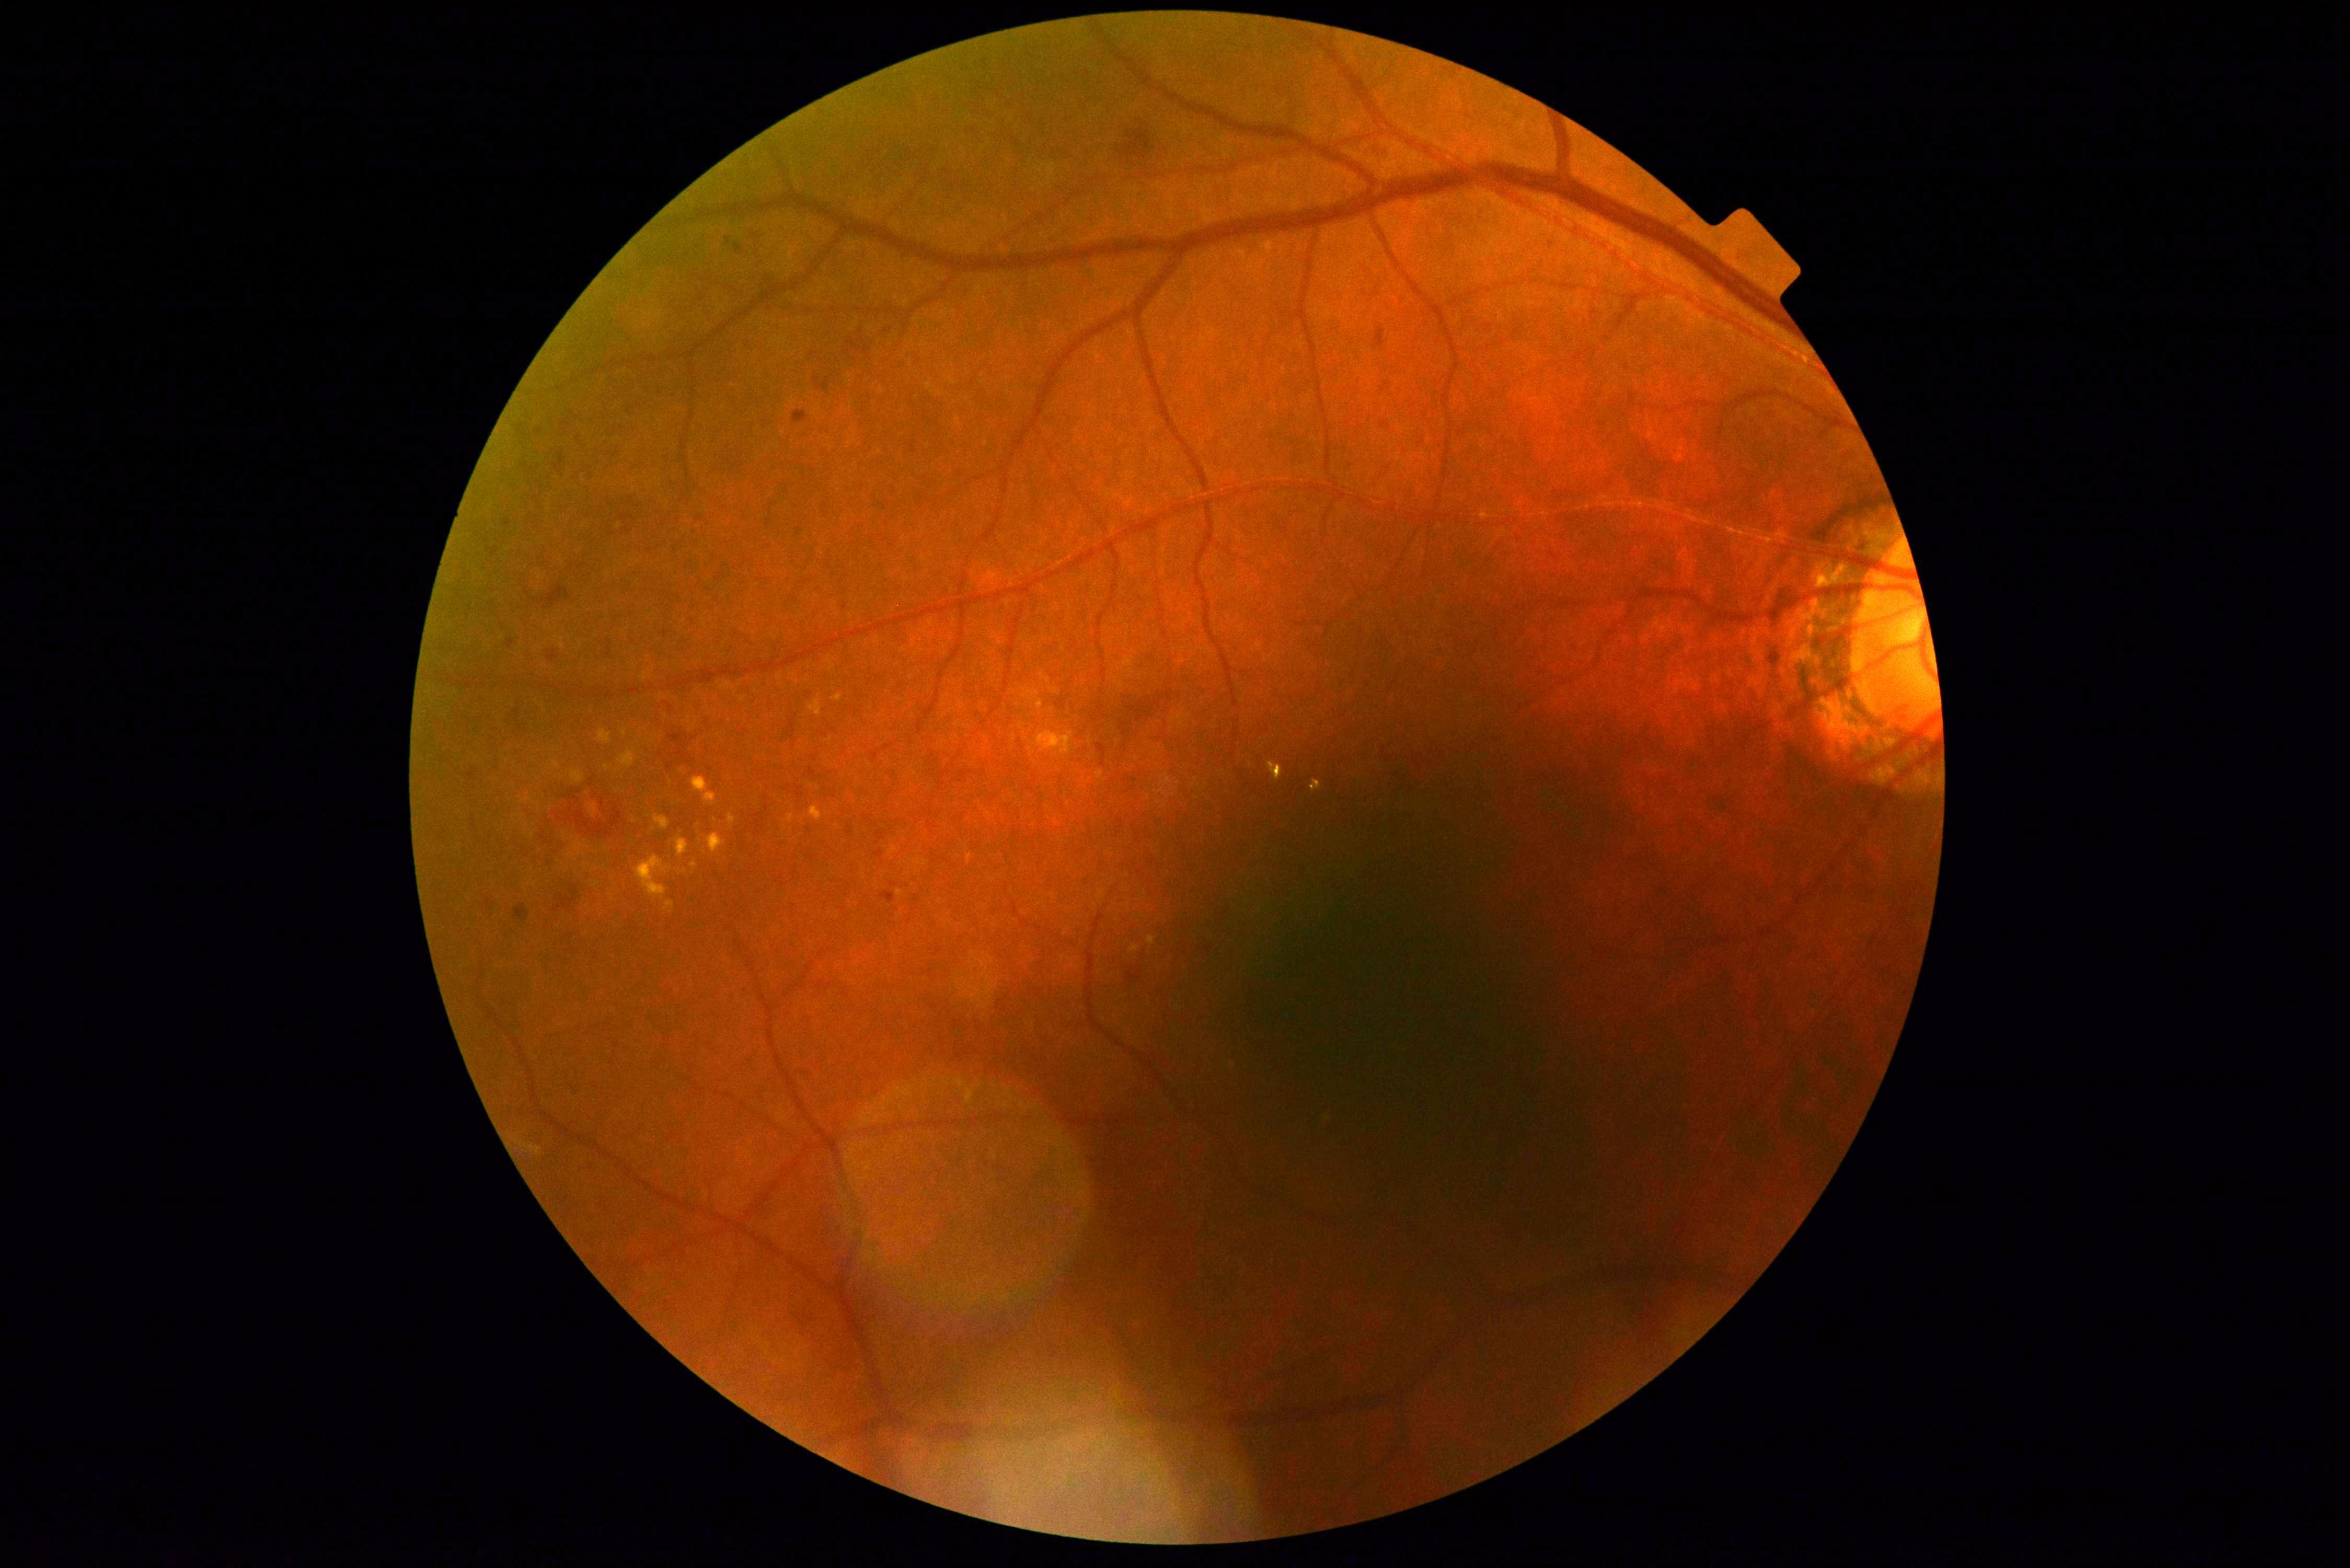

Retinopathy is grade 2 (moderate NPDR).